Phoenix ICON wide-field infant fundus image:
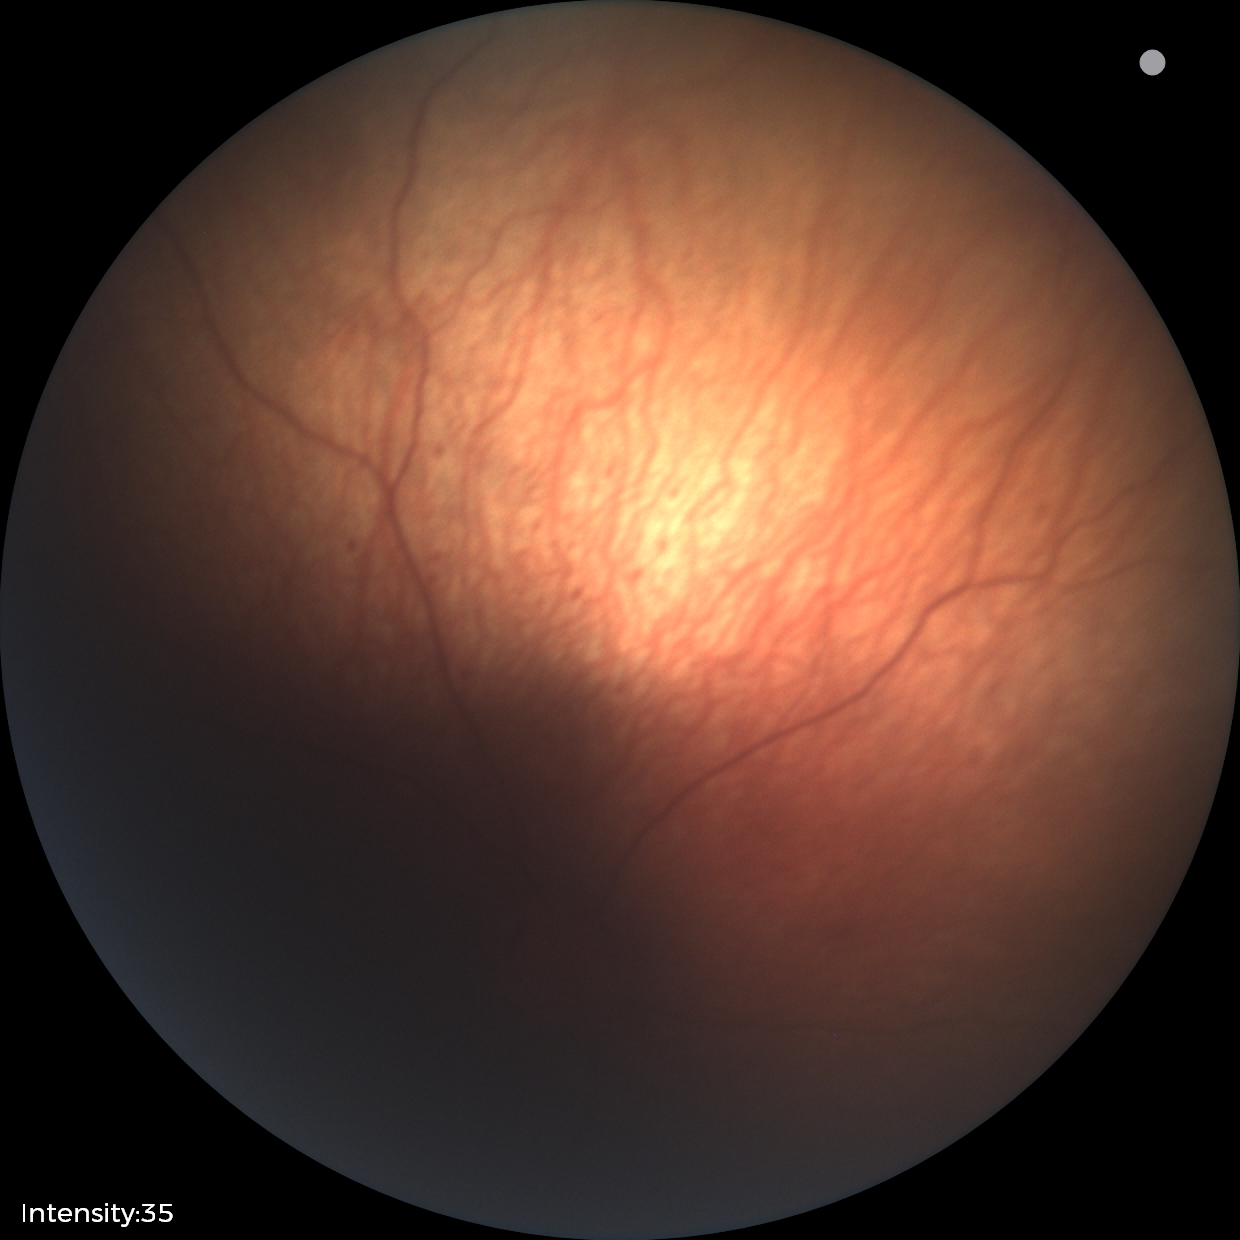 Examination diagnosed as status post ROP.
Plus disease absent.